Diabetic retinopathy graded by the modified Davis classification — 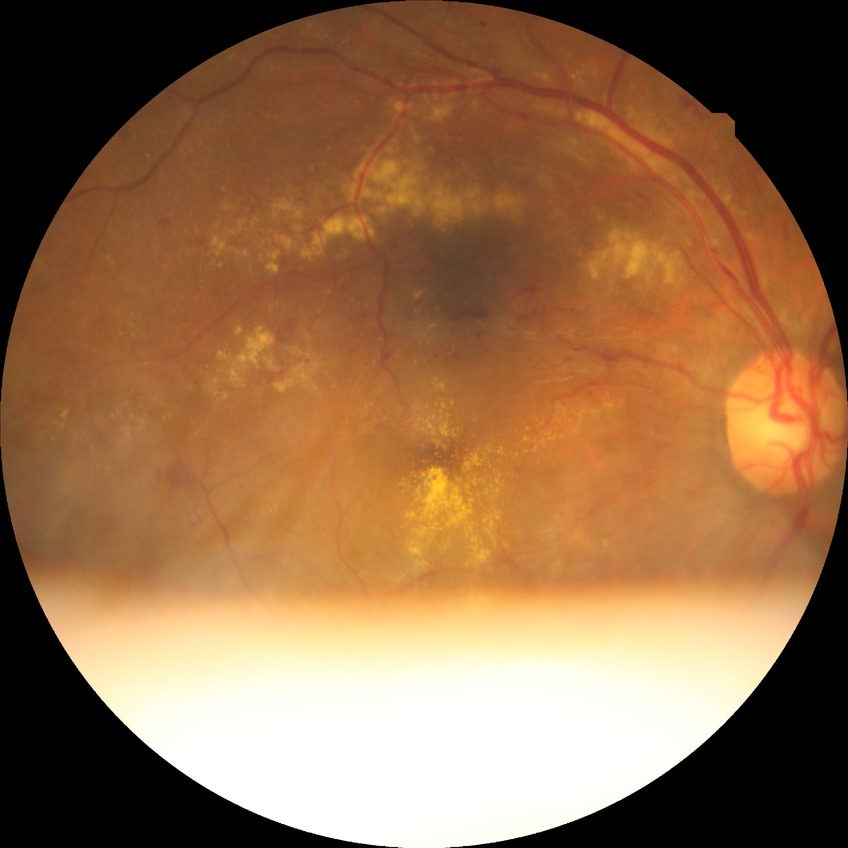 davis_grade: PPDR